Infant wide-field retinal image; image size 640x480: 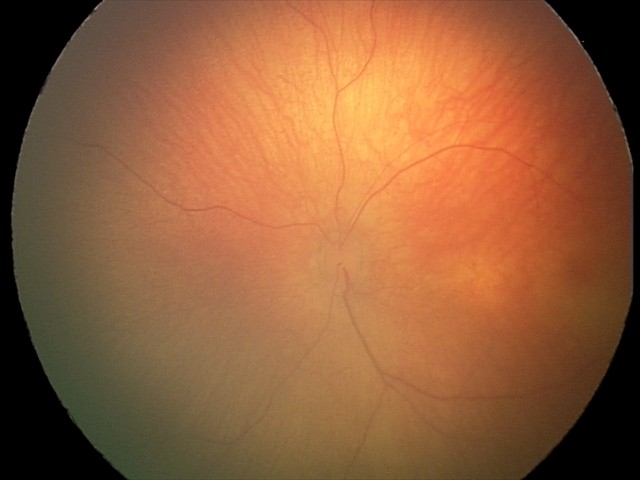

Screening examination with no abnormal retinal findings.